Posterior pole photograph. 848 x 848 pixels. Nonmydriatic. Davis DR grading
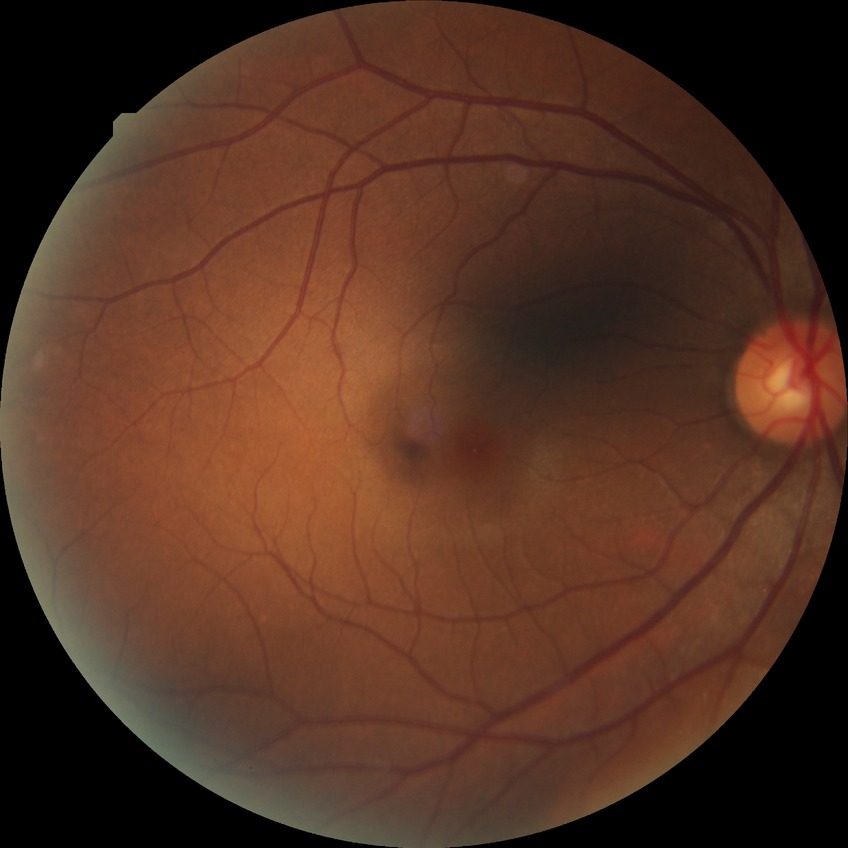
No diabetic retinal disease findings.
Davis stage: NDR.